45° field of view, fundus photo:
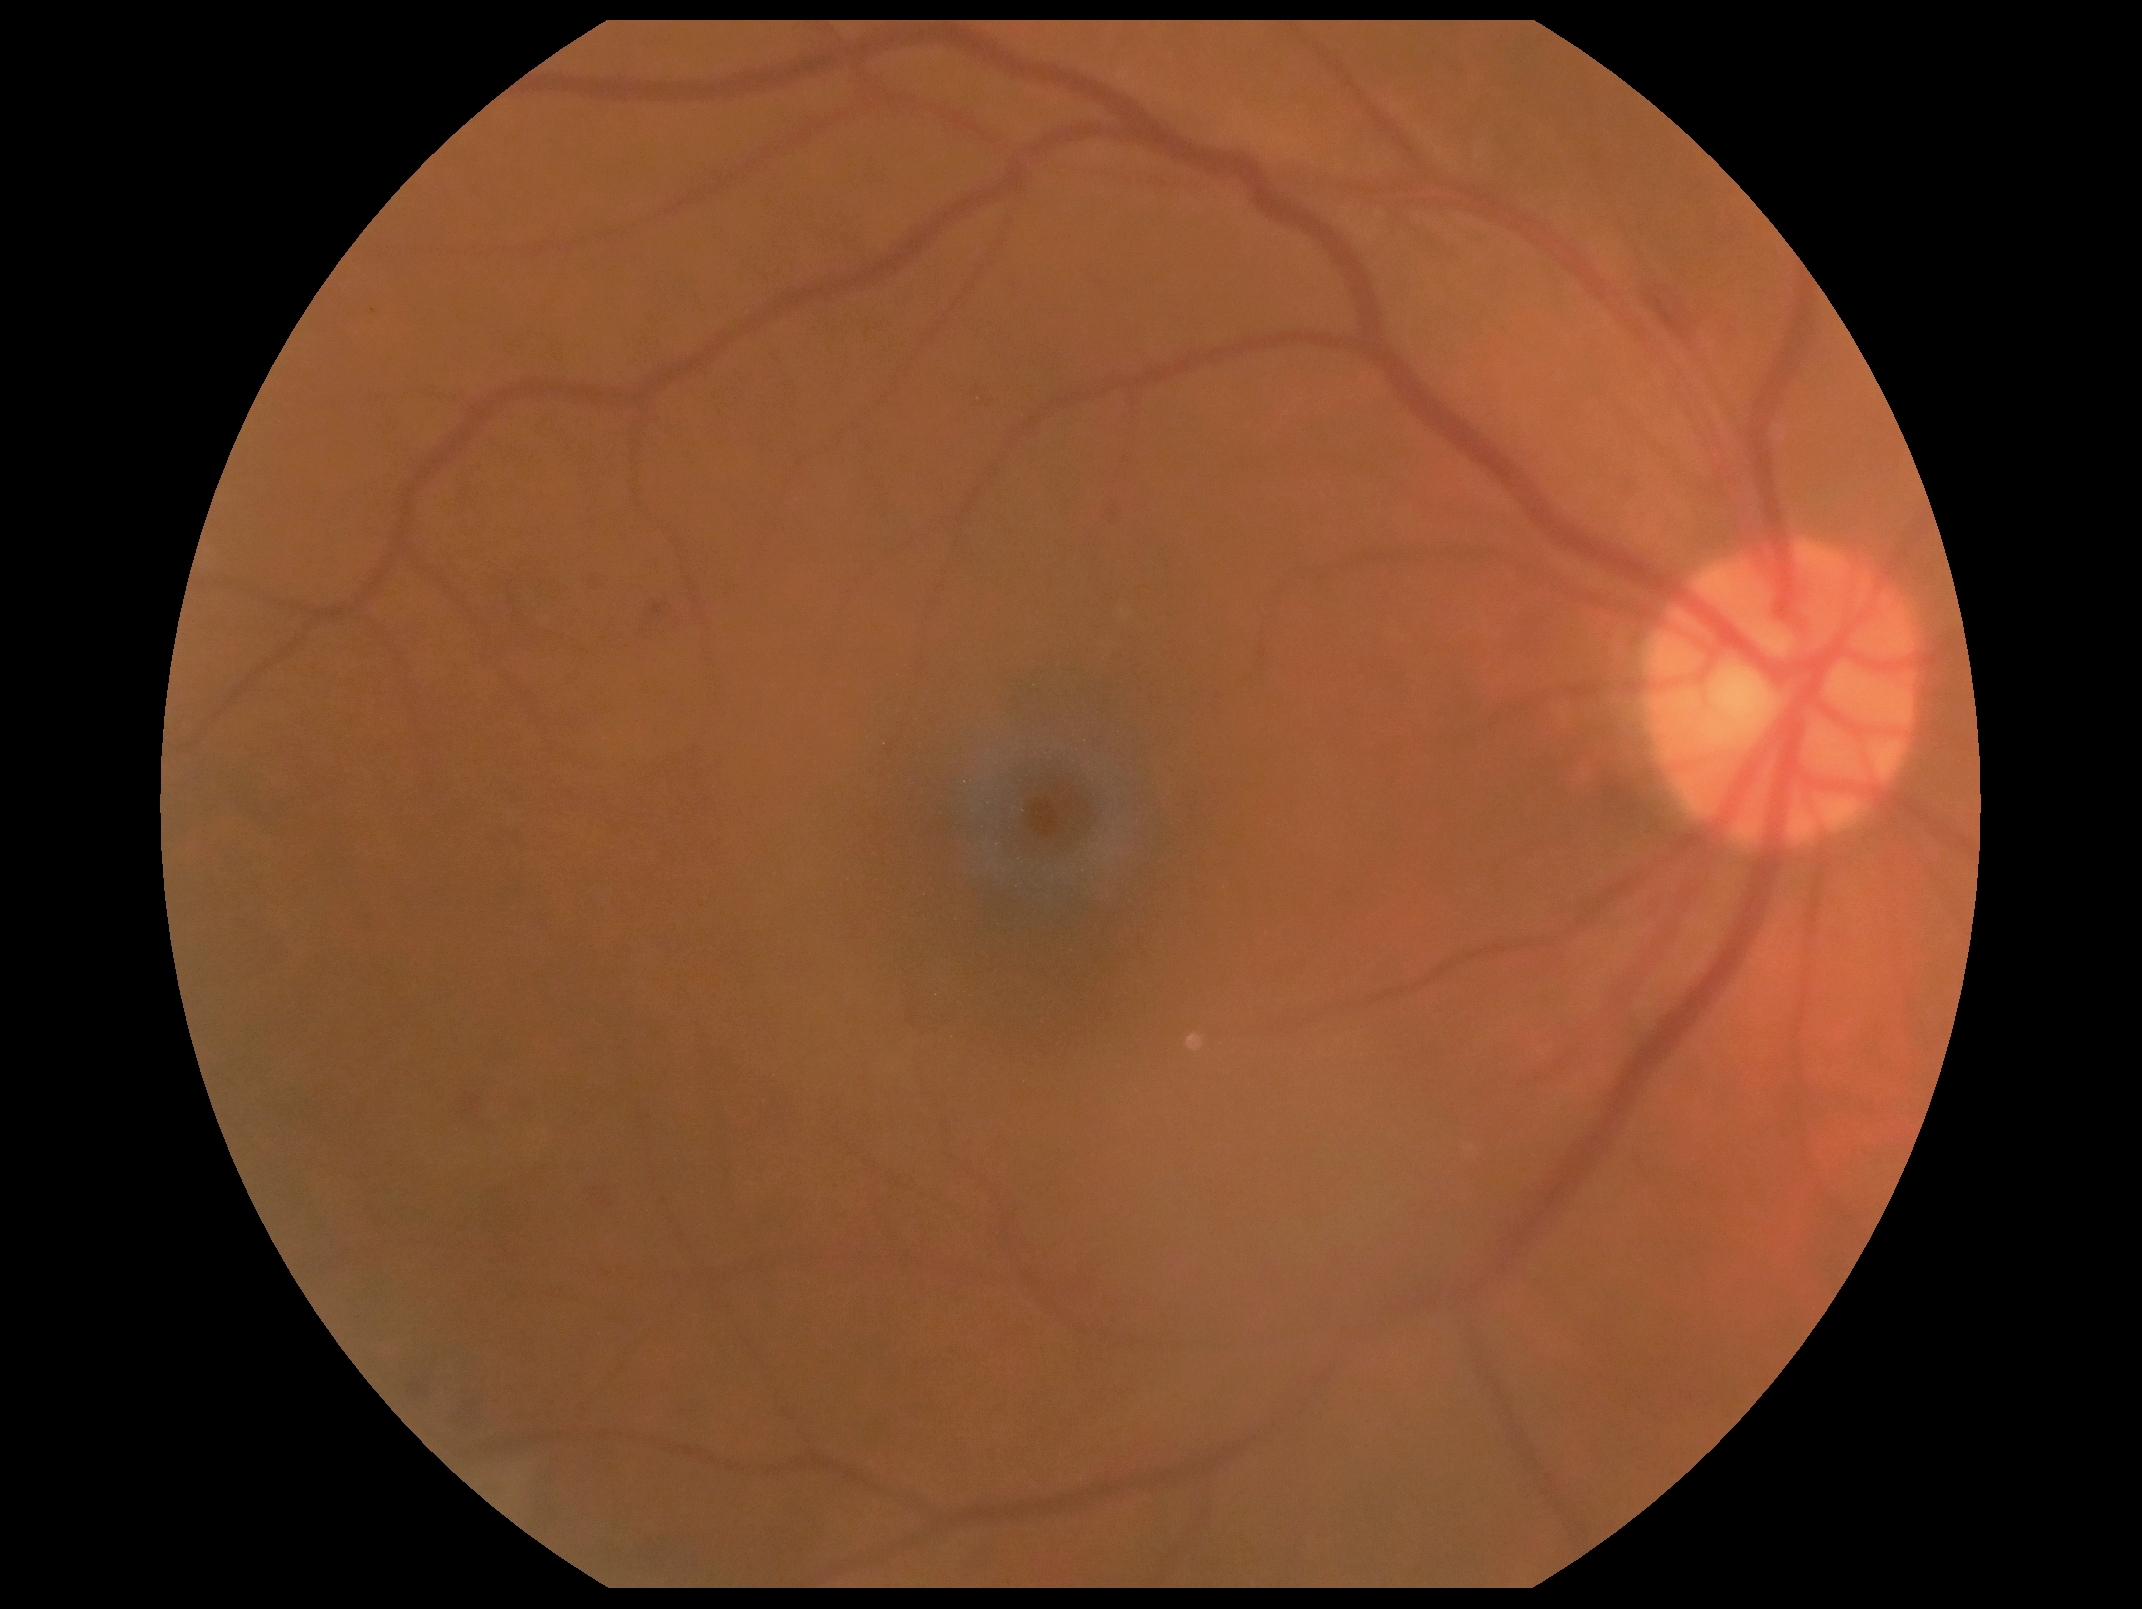

Diabetic retinopathy severity: 2/4. Disease class: non-proliferative diabetic retinopathy.